45-degree field of view: 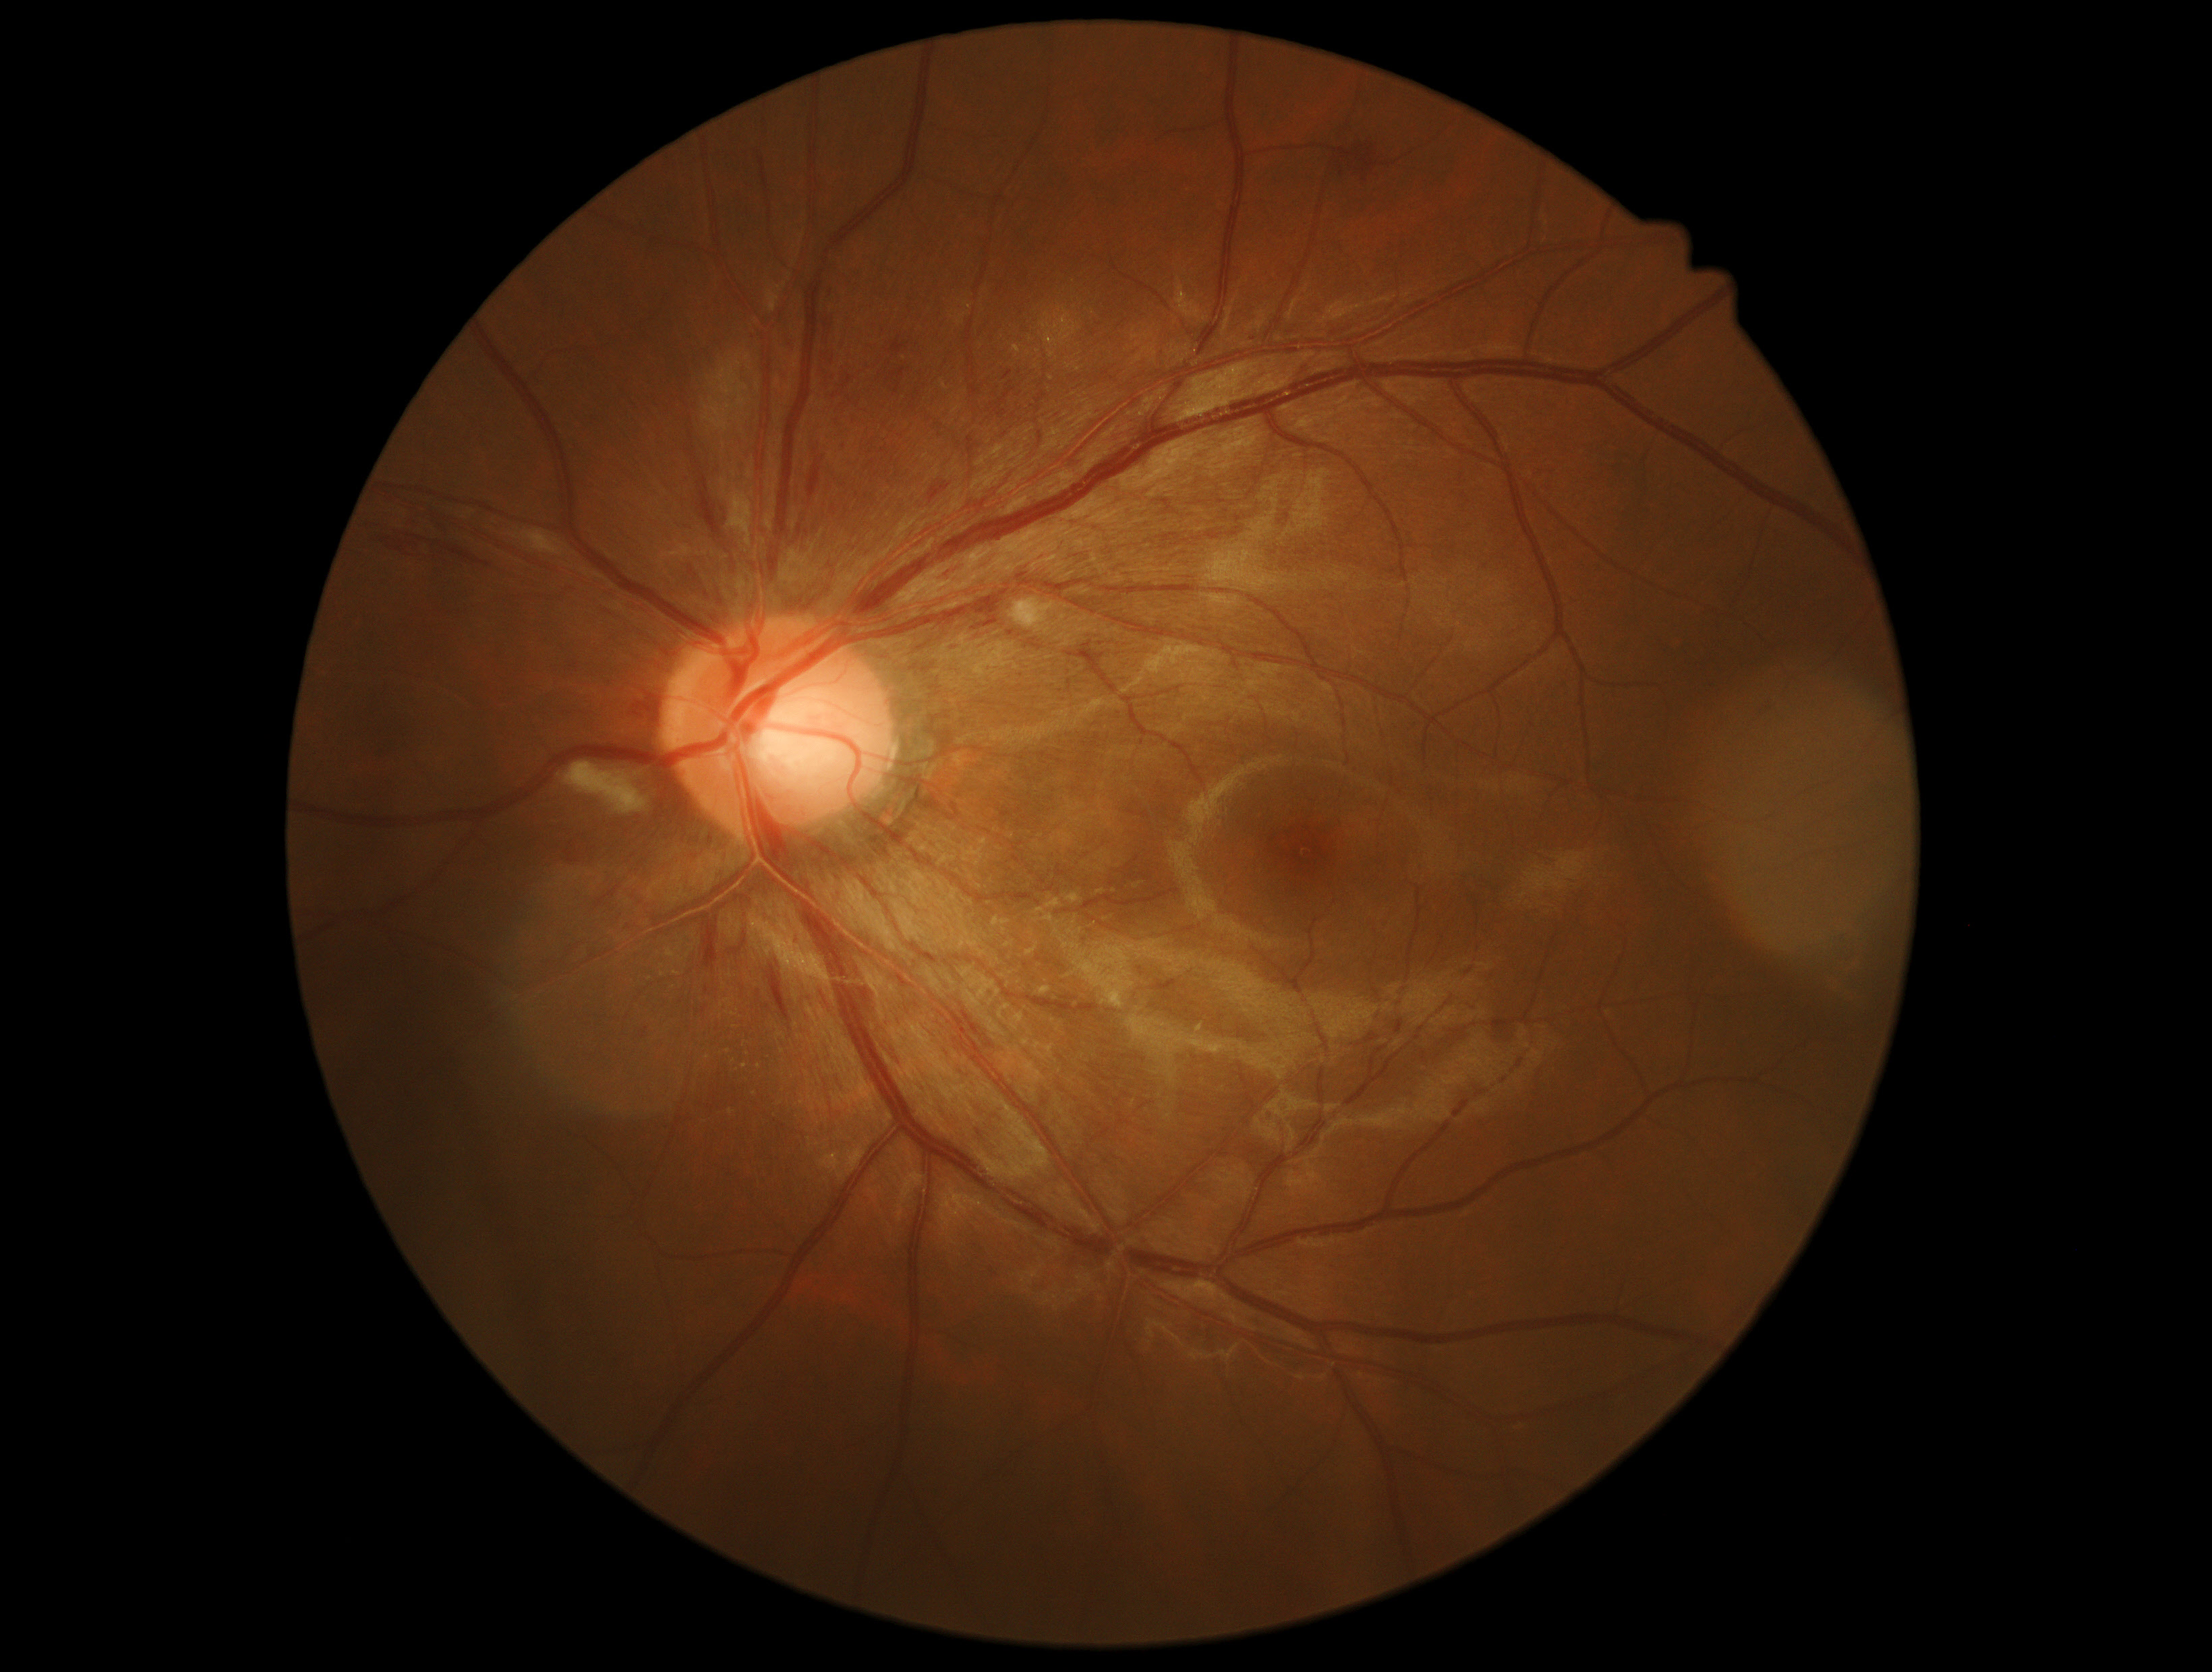 {
  "dr_grade": "grade 2 (moderate NPDR)",
  "dr_category": "non-proliferative diabetic retinopathy"
}